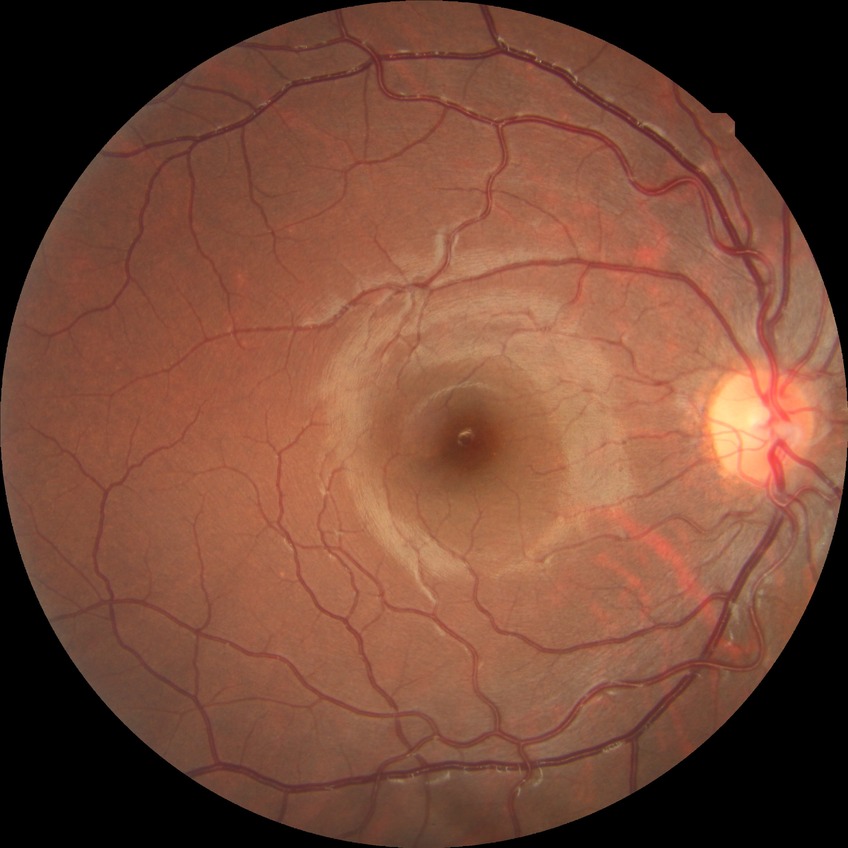
Diabetic retinopathy (DR): no diabetic retinopathy (NDR).